CFP. 45-degree field of view: 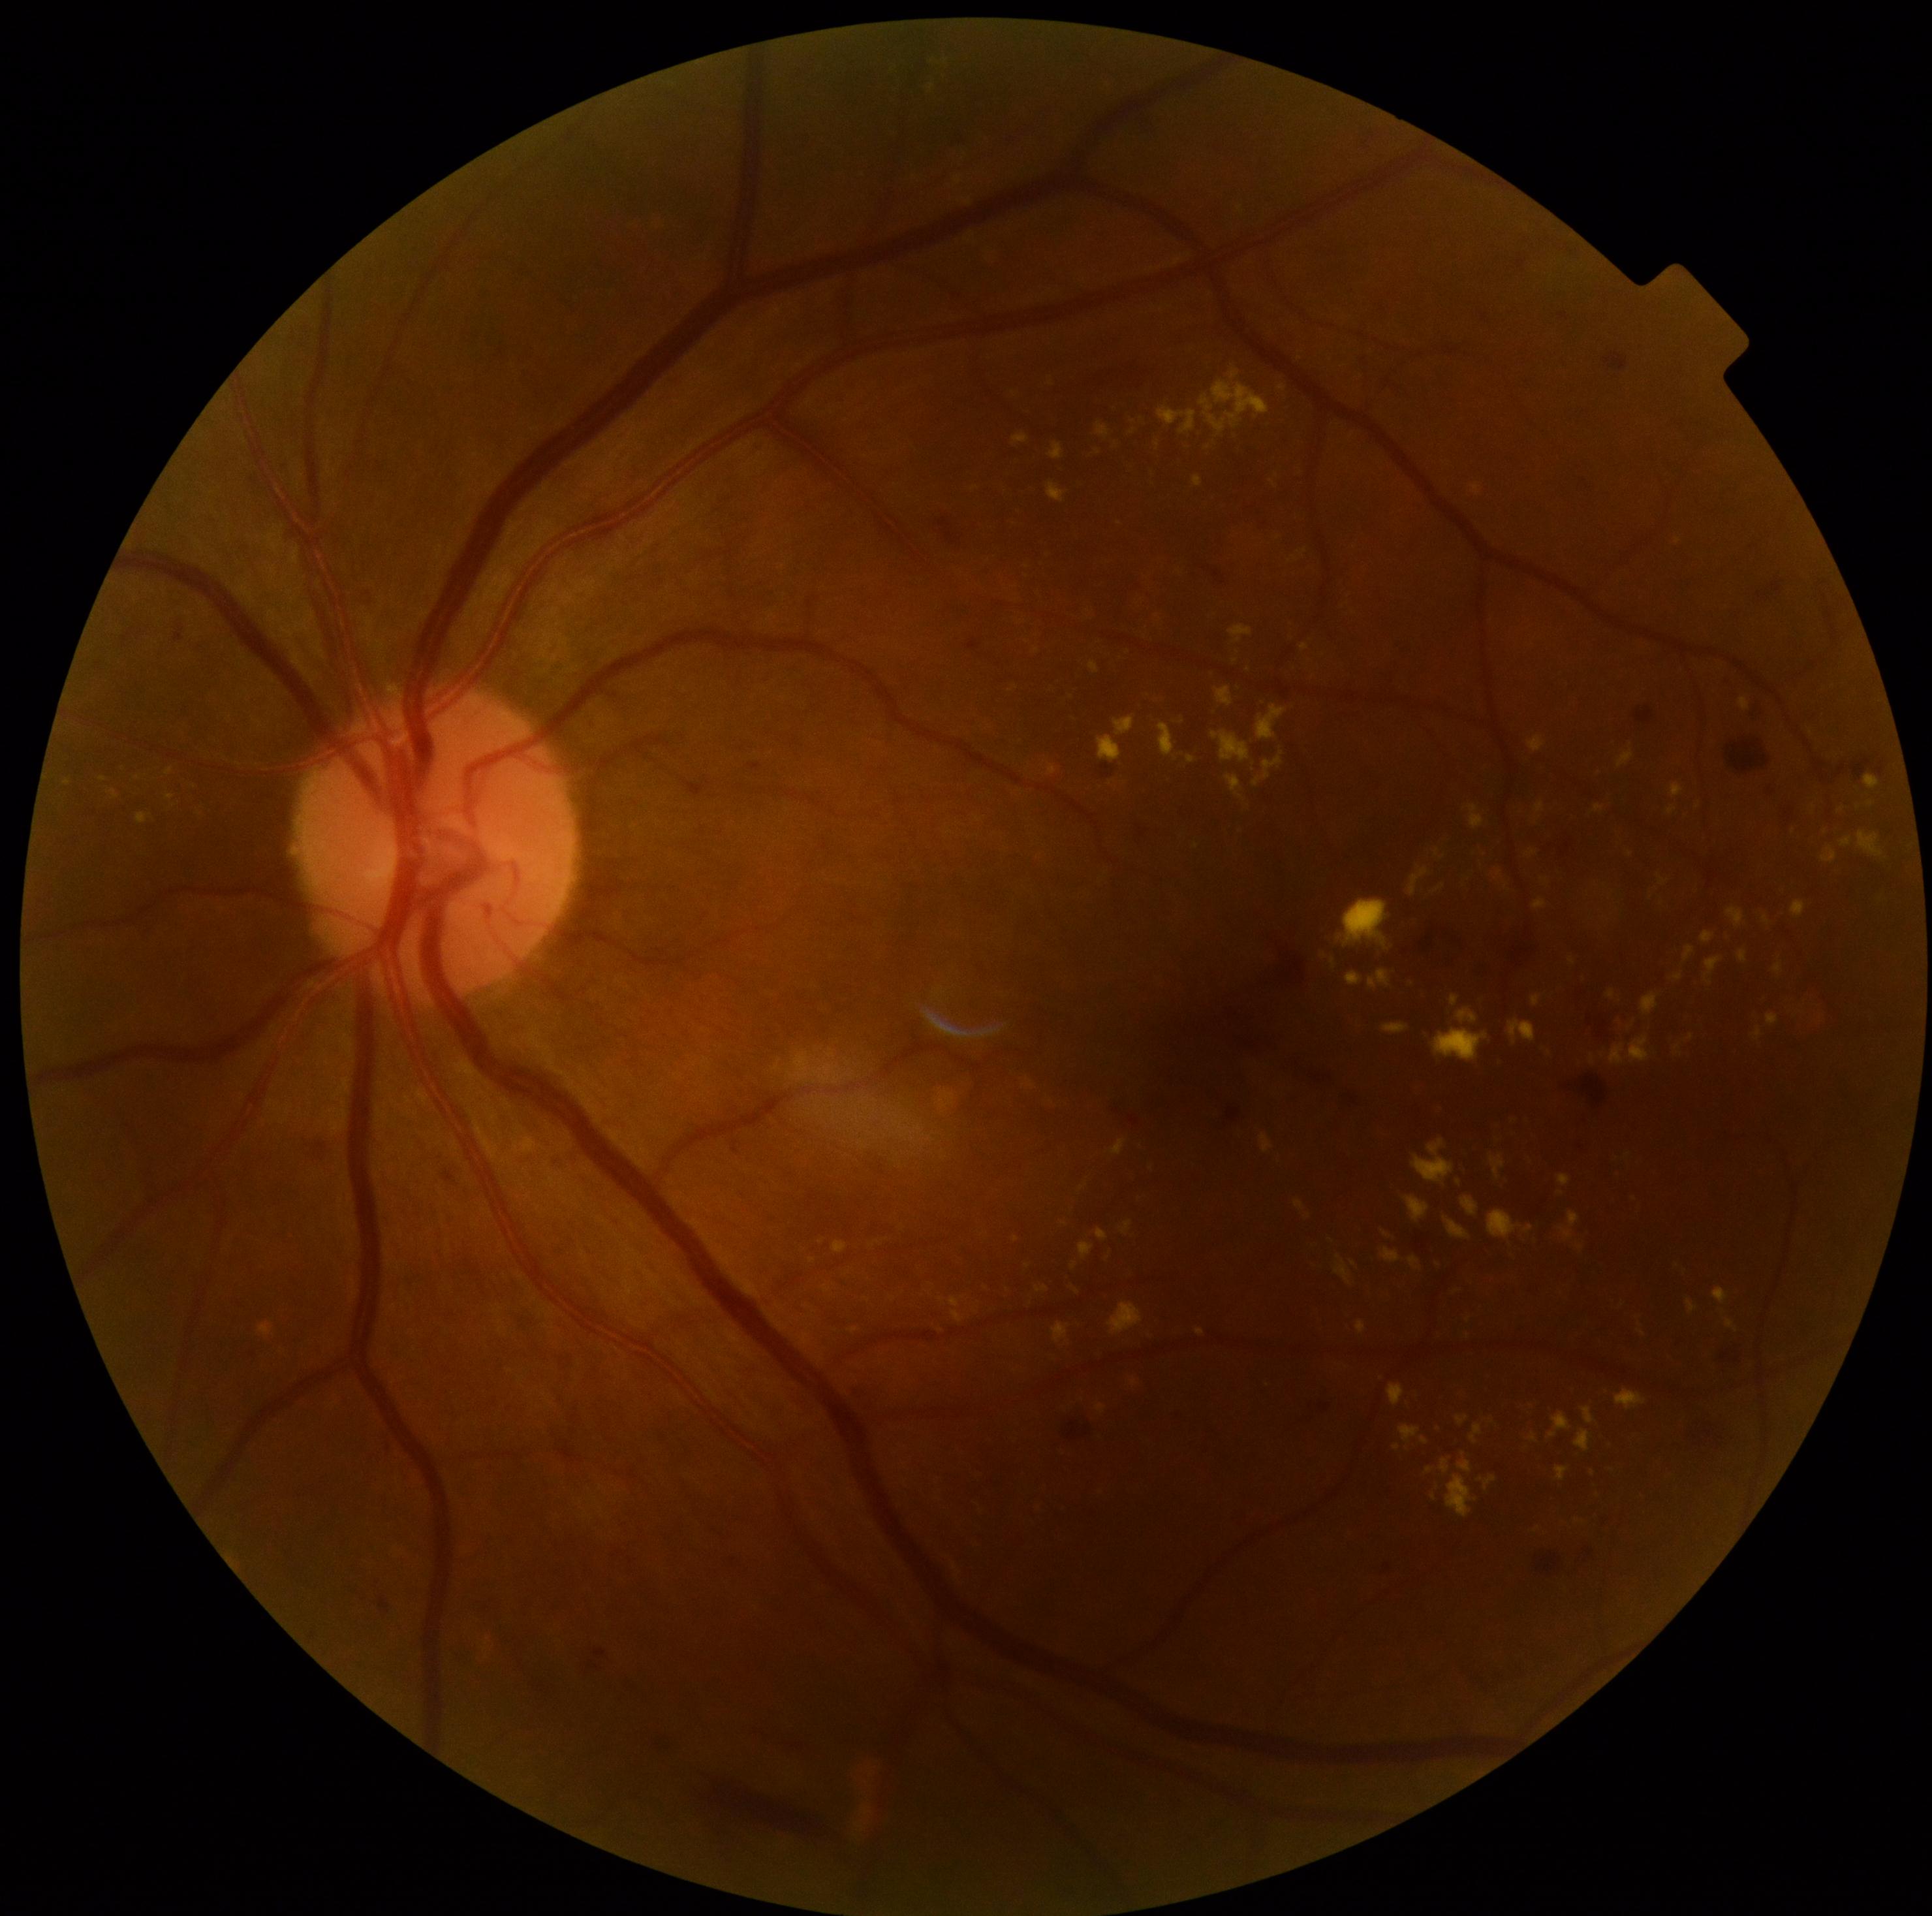
{"partial": true, "dr_grade": 2, "dr_grade_name": "moderate NPDR", "lesions": {"ex": [[1132, 1379, 1138, 1387], [951, 1296, 964, 1323], [787, 1050, 847, 1086], [1089, 662, 1100, 675], [1121, 1221, 1132, 1235], [1561, 1212, 1579, 1242], [1508, 1020, 1537, 1046], [1098, 1405, 1106, 1413], [1347, 973, 1363, 986], [1226, 776, 1243, 799], [1434, 885, 1446, 893], [1260, 1133, 1273, 1154], [1048, 764, 1057, 776]], "ex_small": [[1397, 1447], [137, 779], [807, 1306], [1871, 804], [1825, 831], [1334, 963]]}}